45° FOV · 1932 x 1910 pixels.
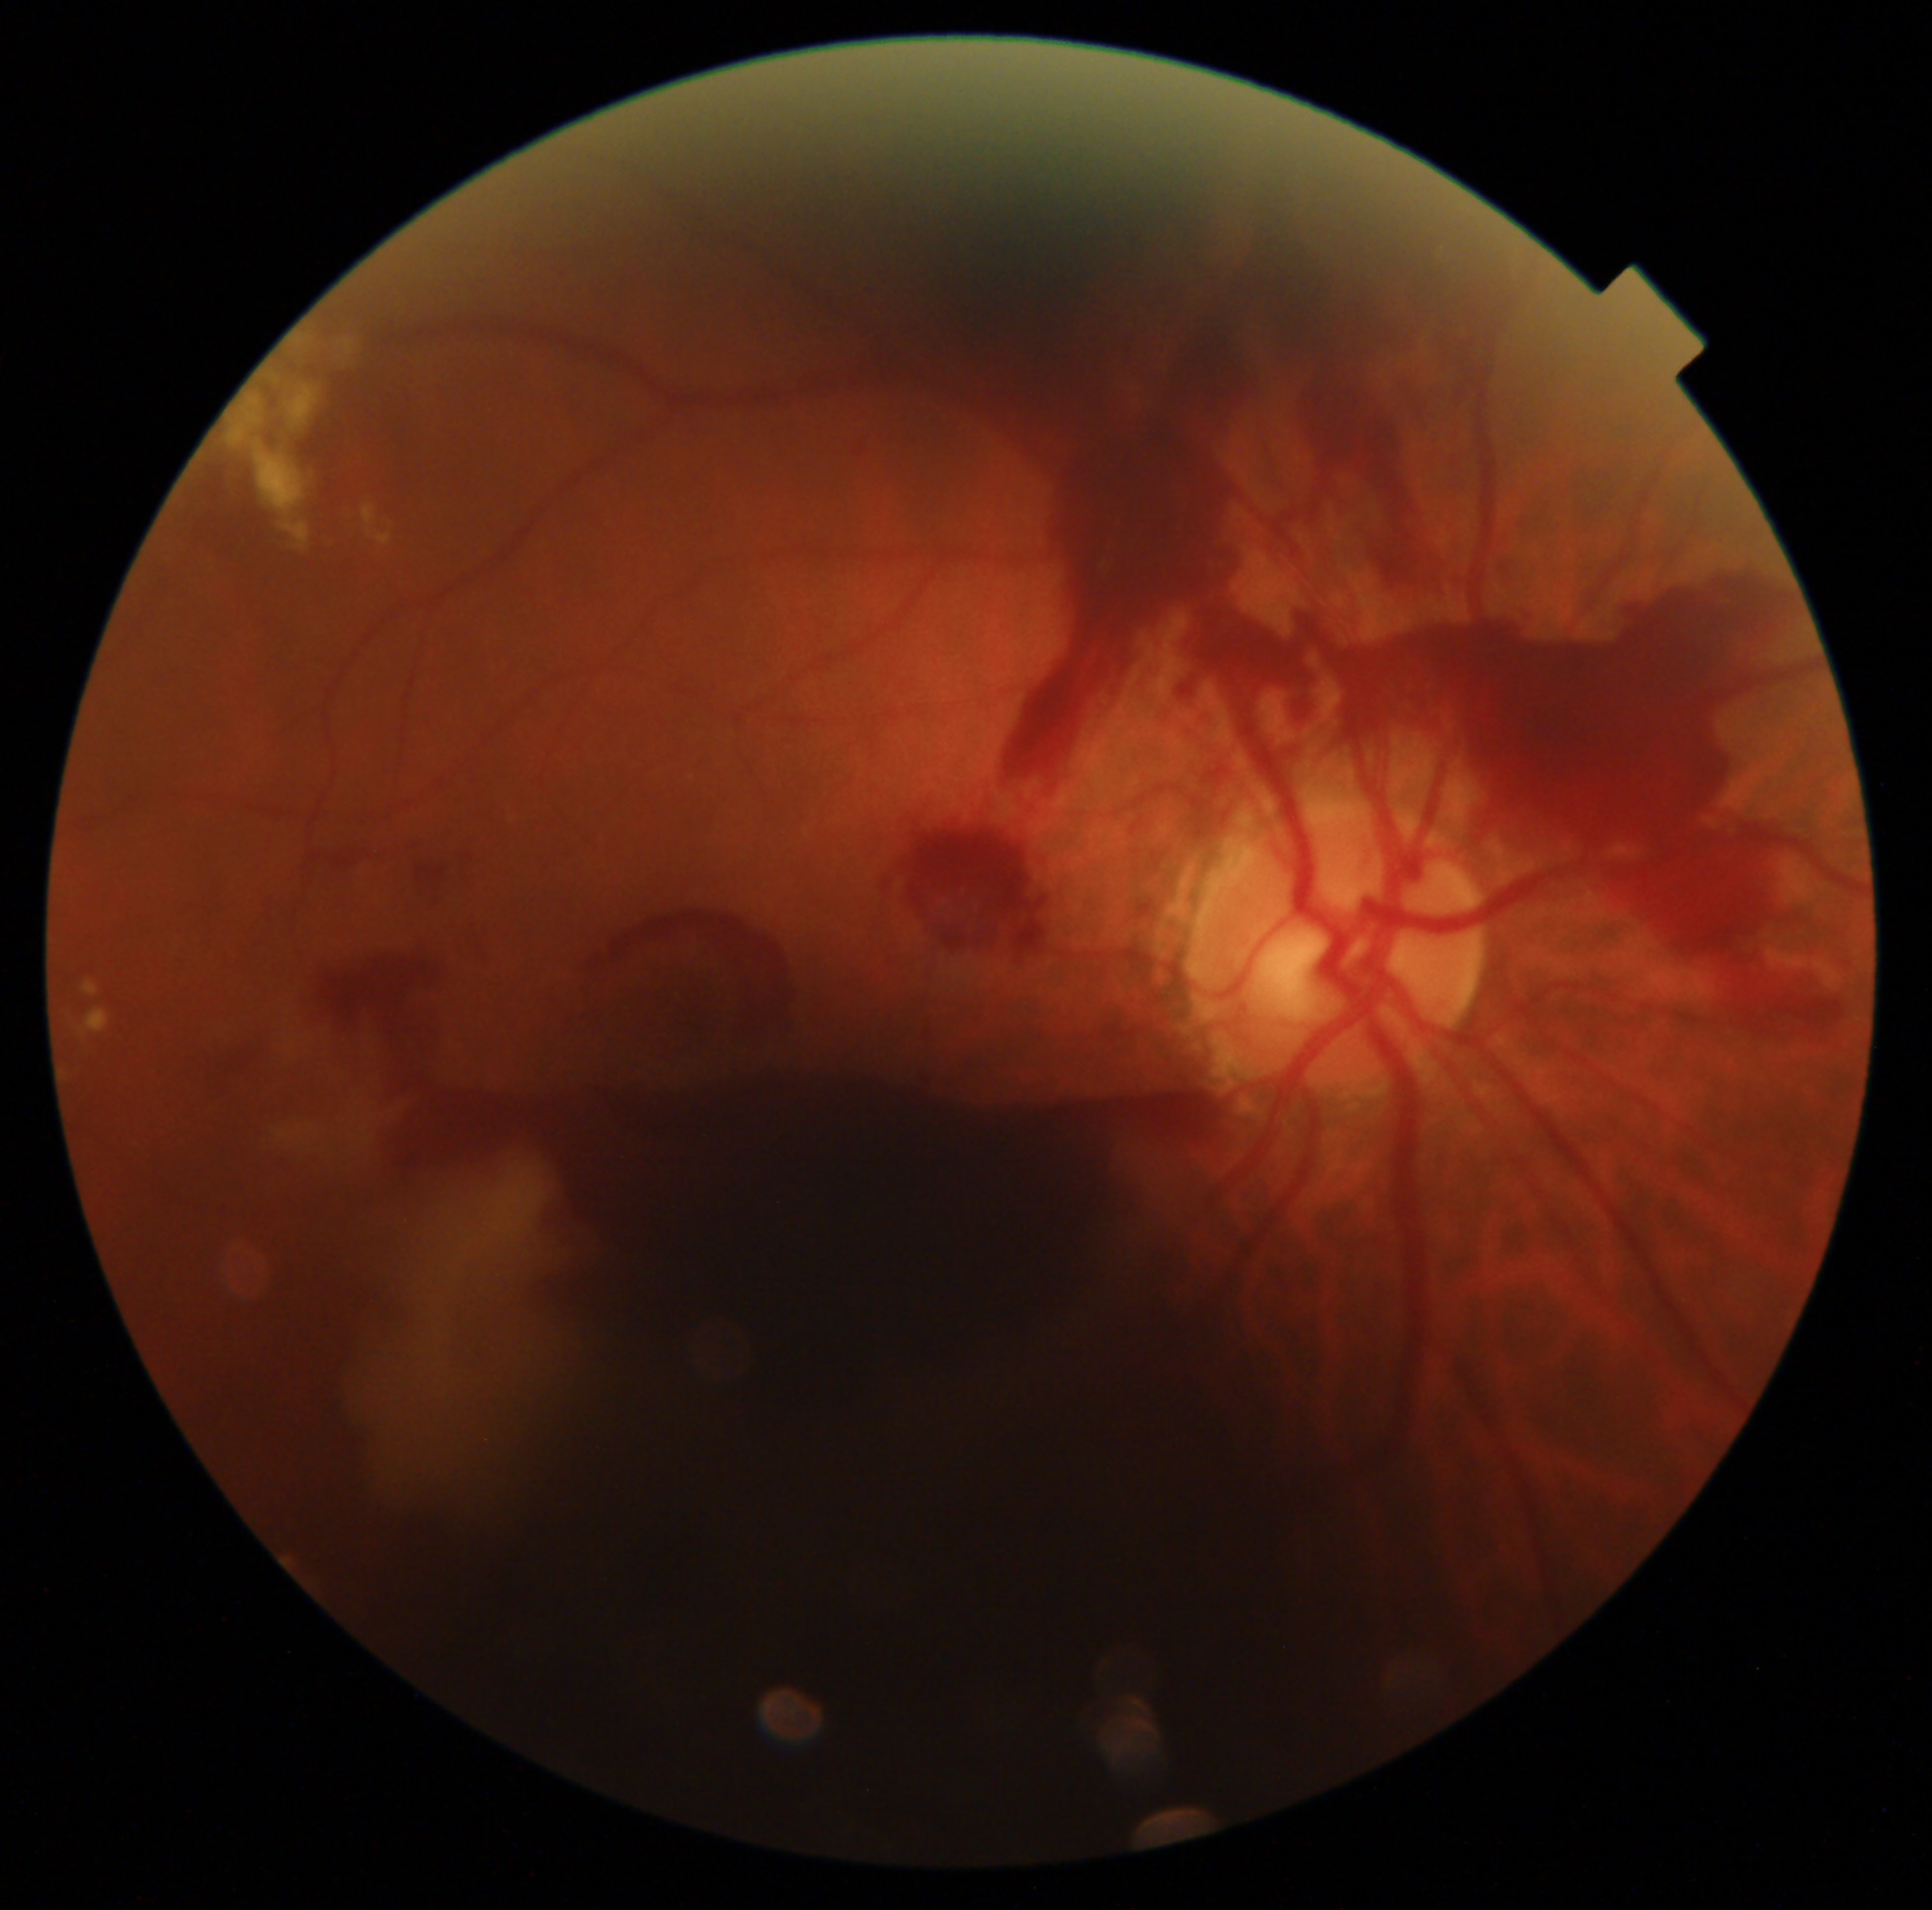
Diabetic retinopathy (DR): proliferative diabetic retinopathy (grade 4).